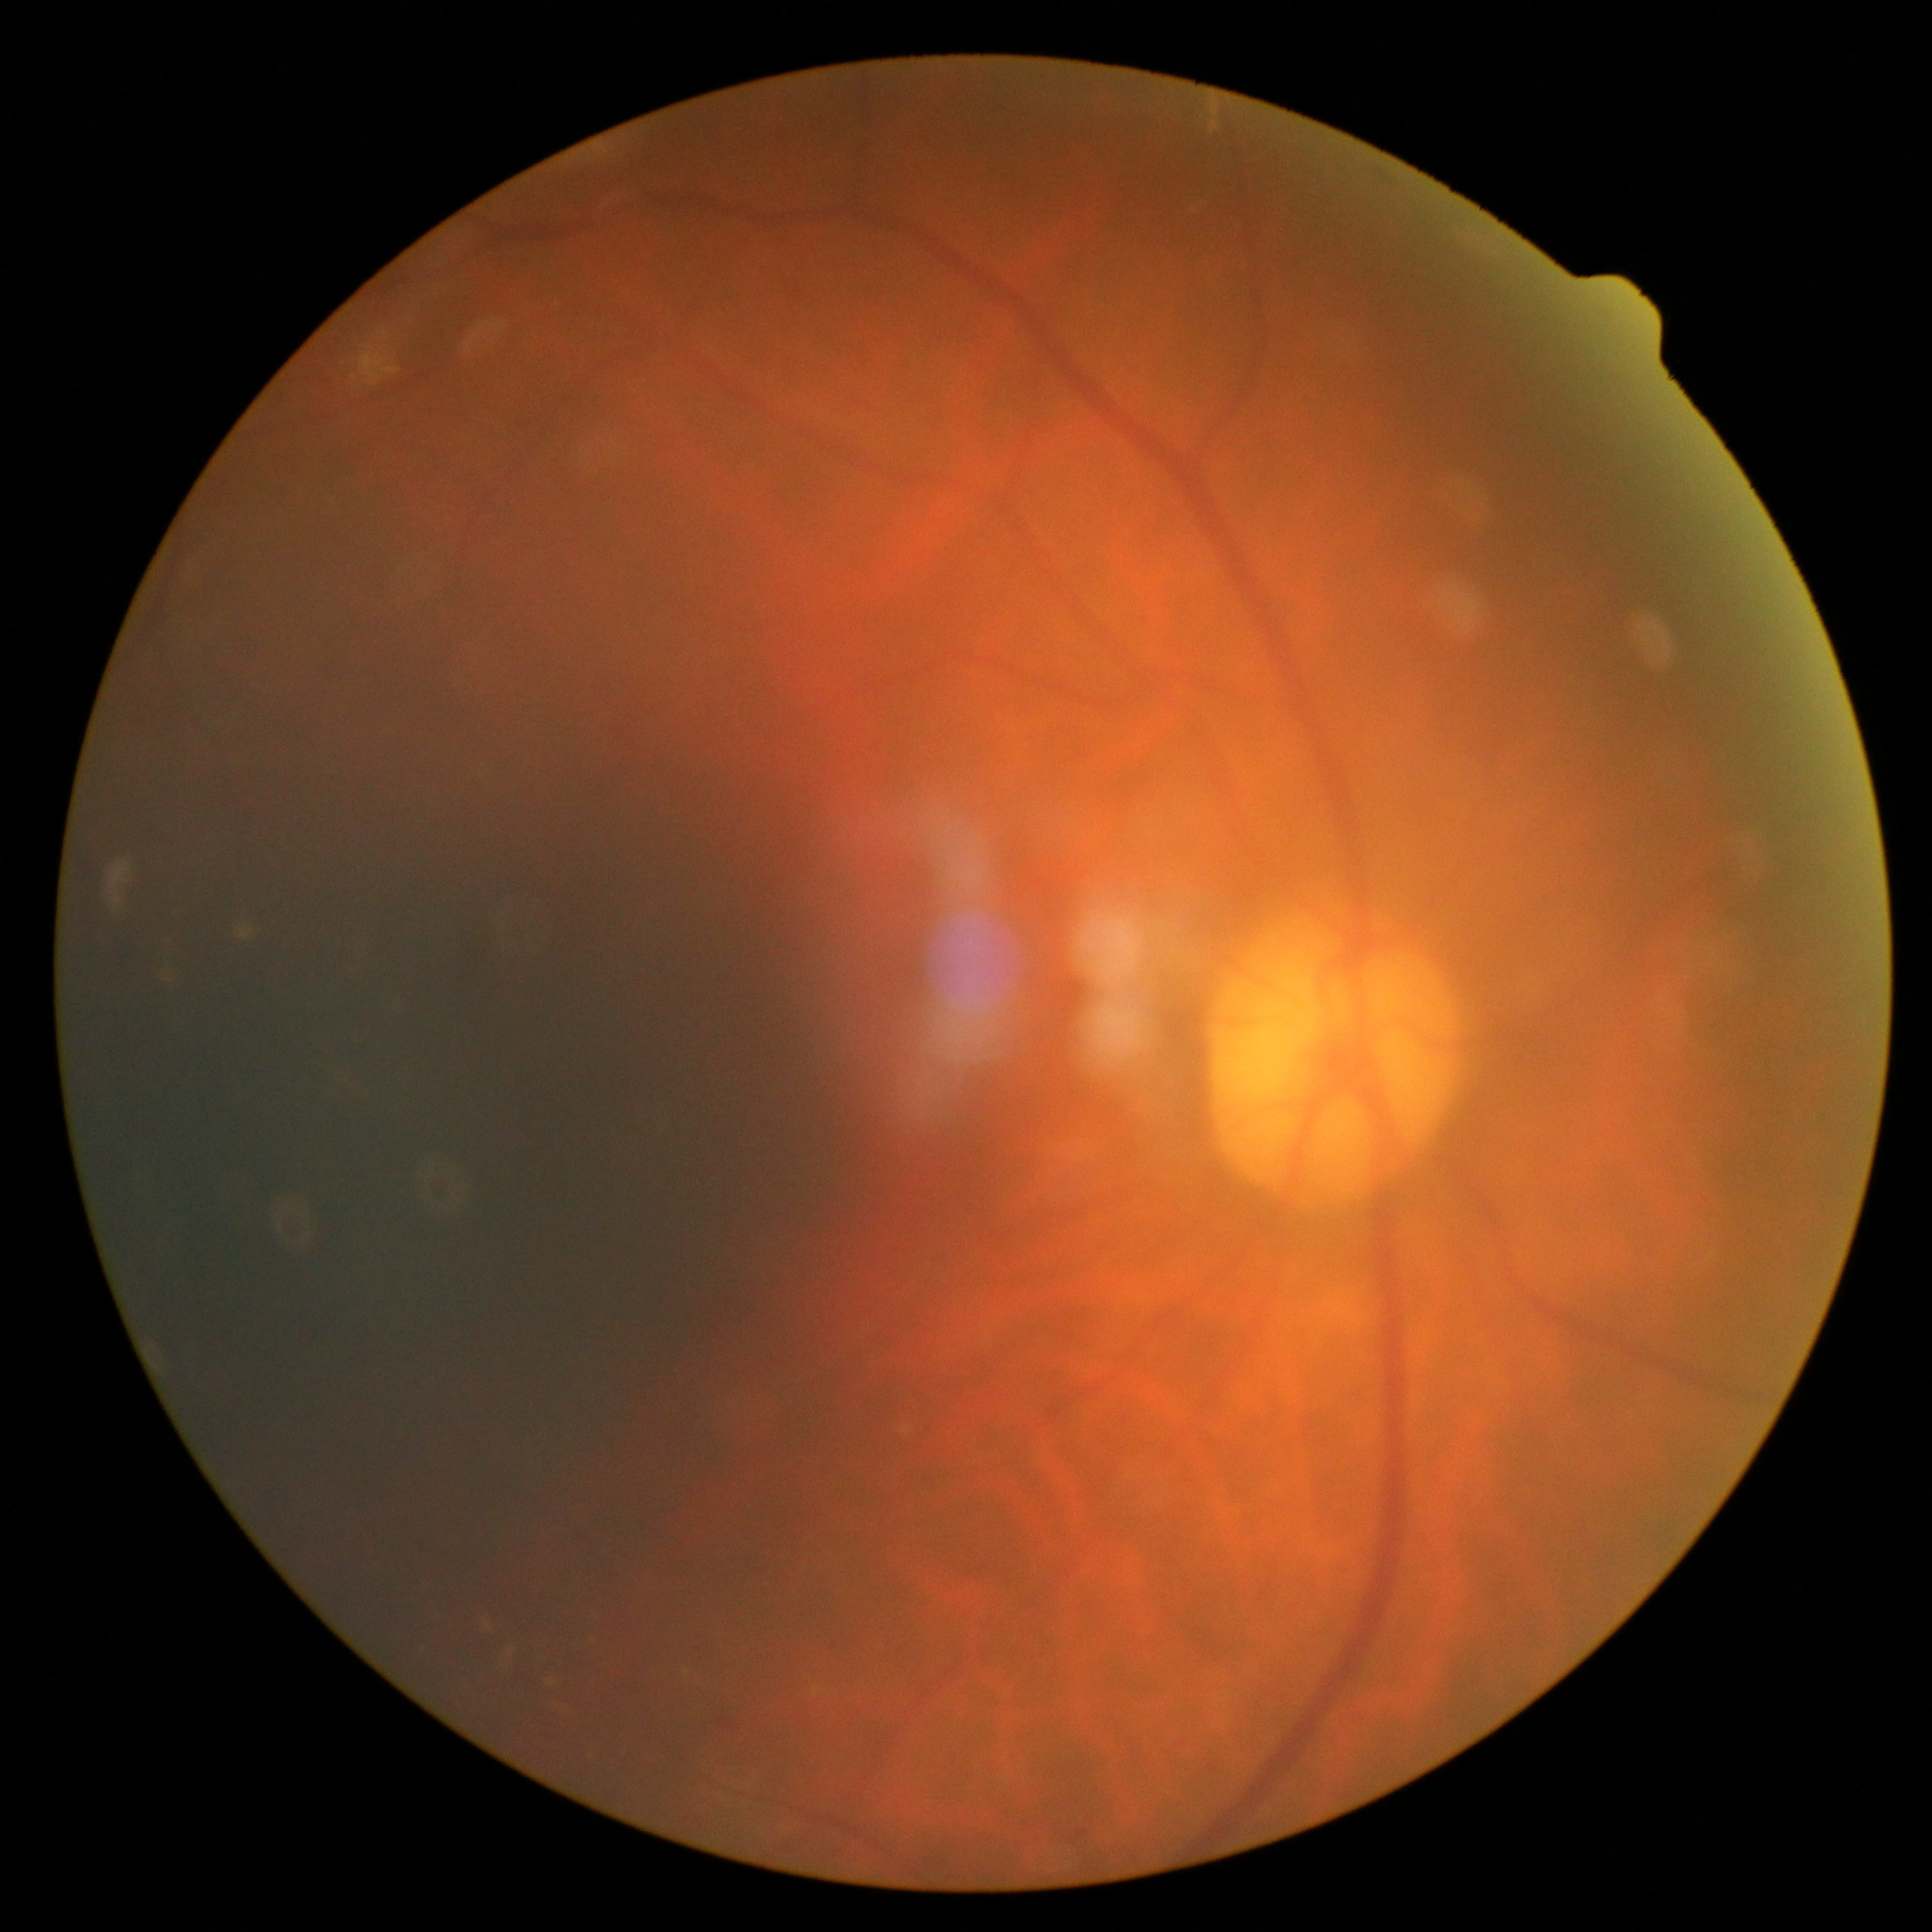

DR grade: 2/4.